Color fundus photograph.
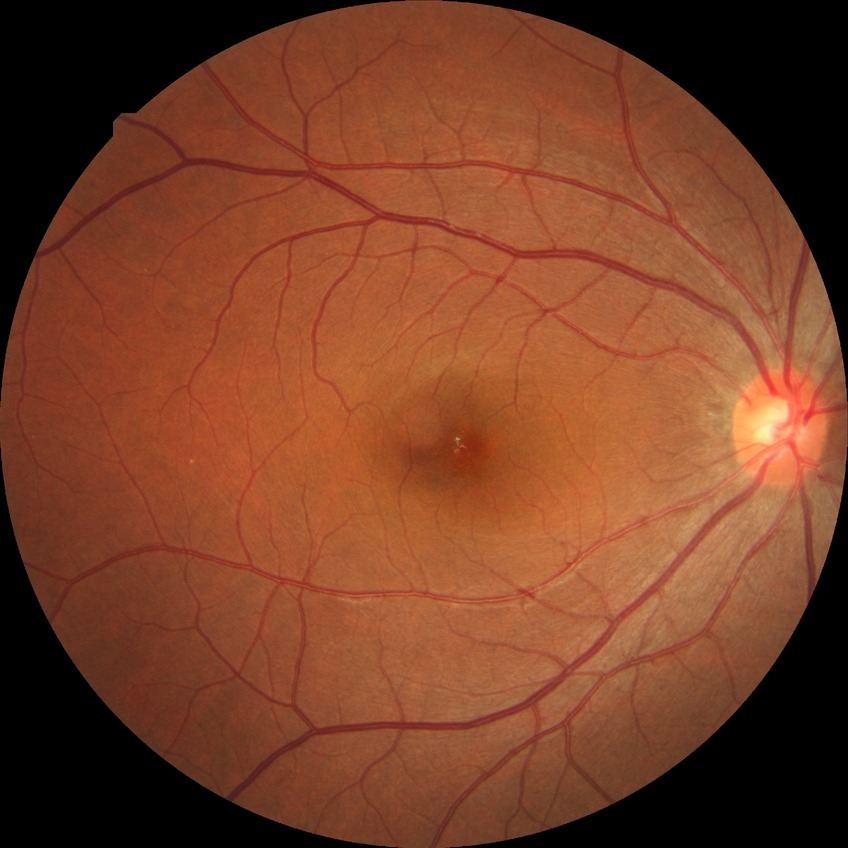 {
  "davis_grade": "NDR"
}